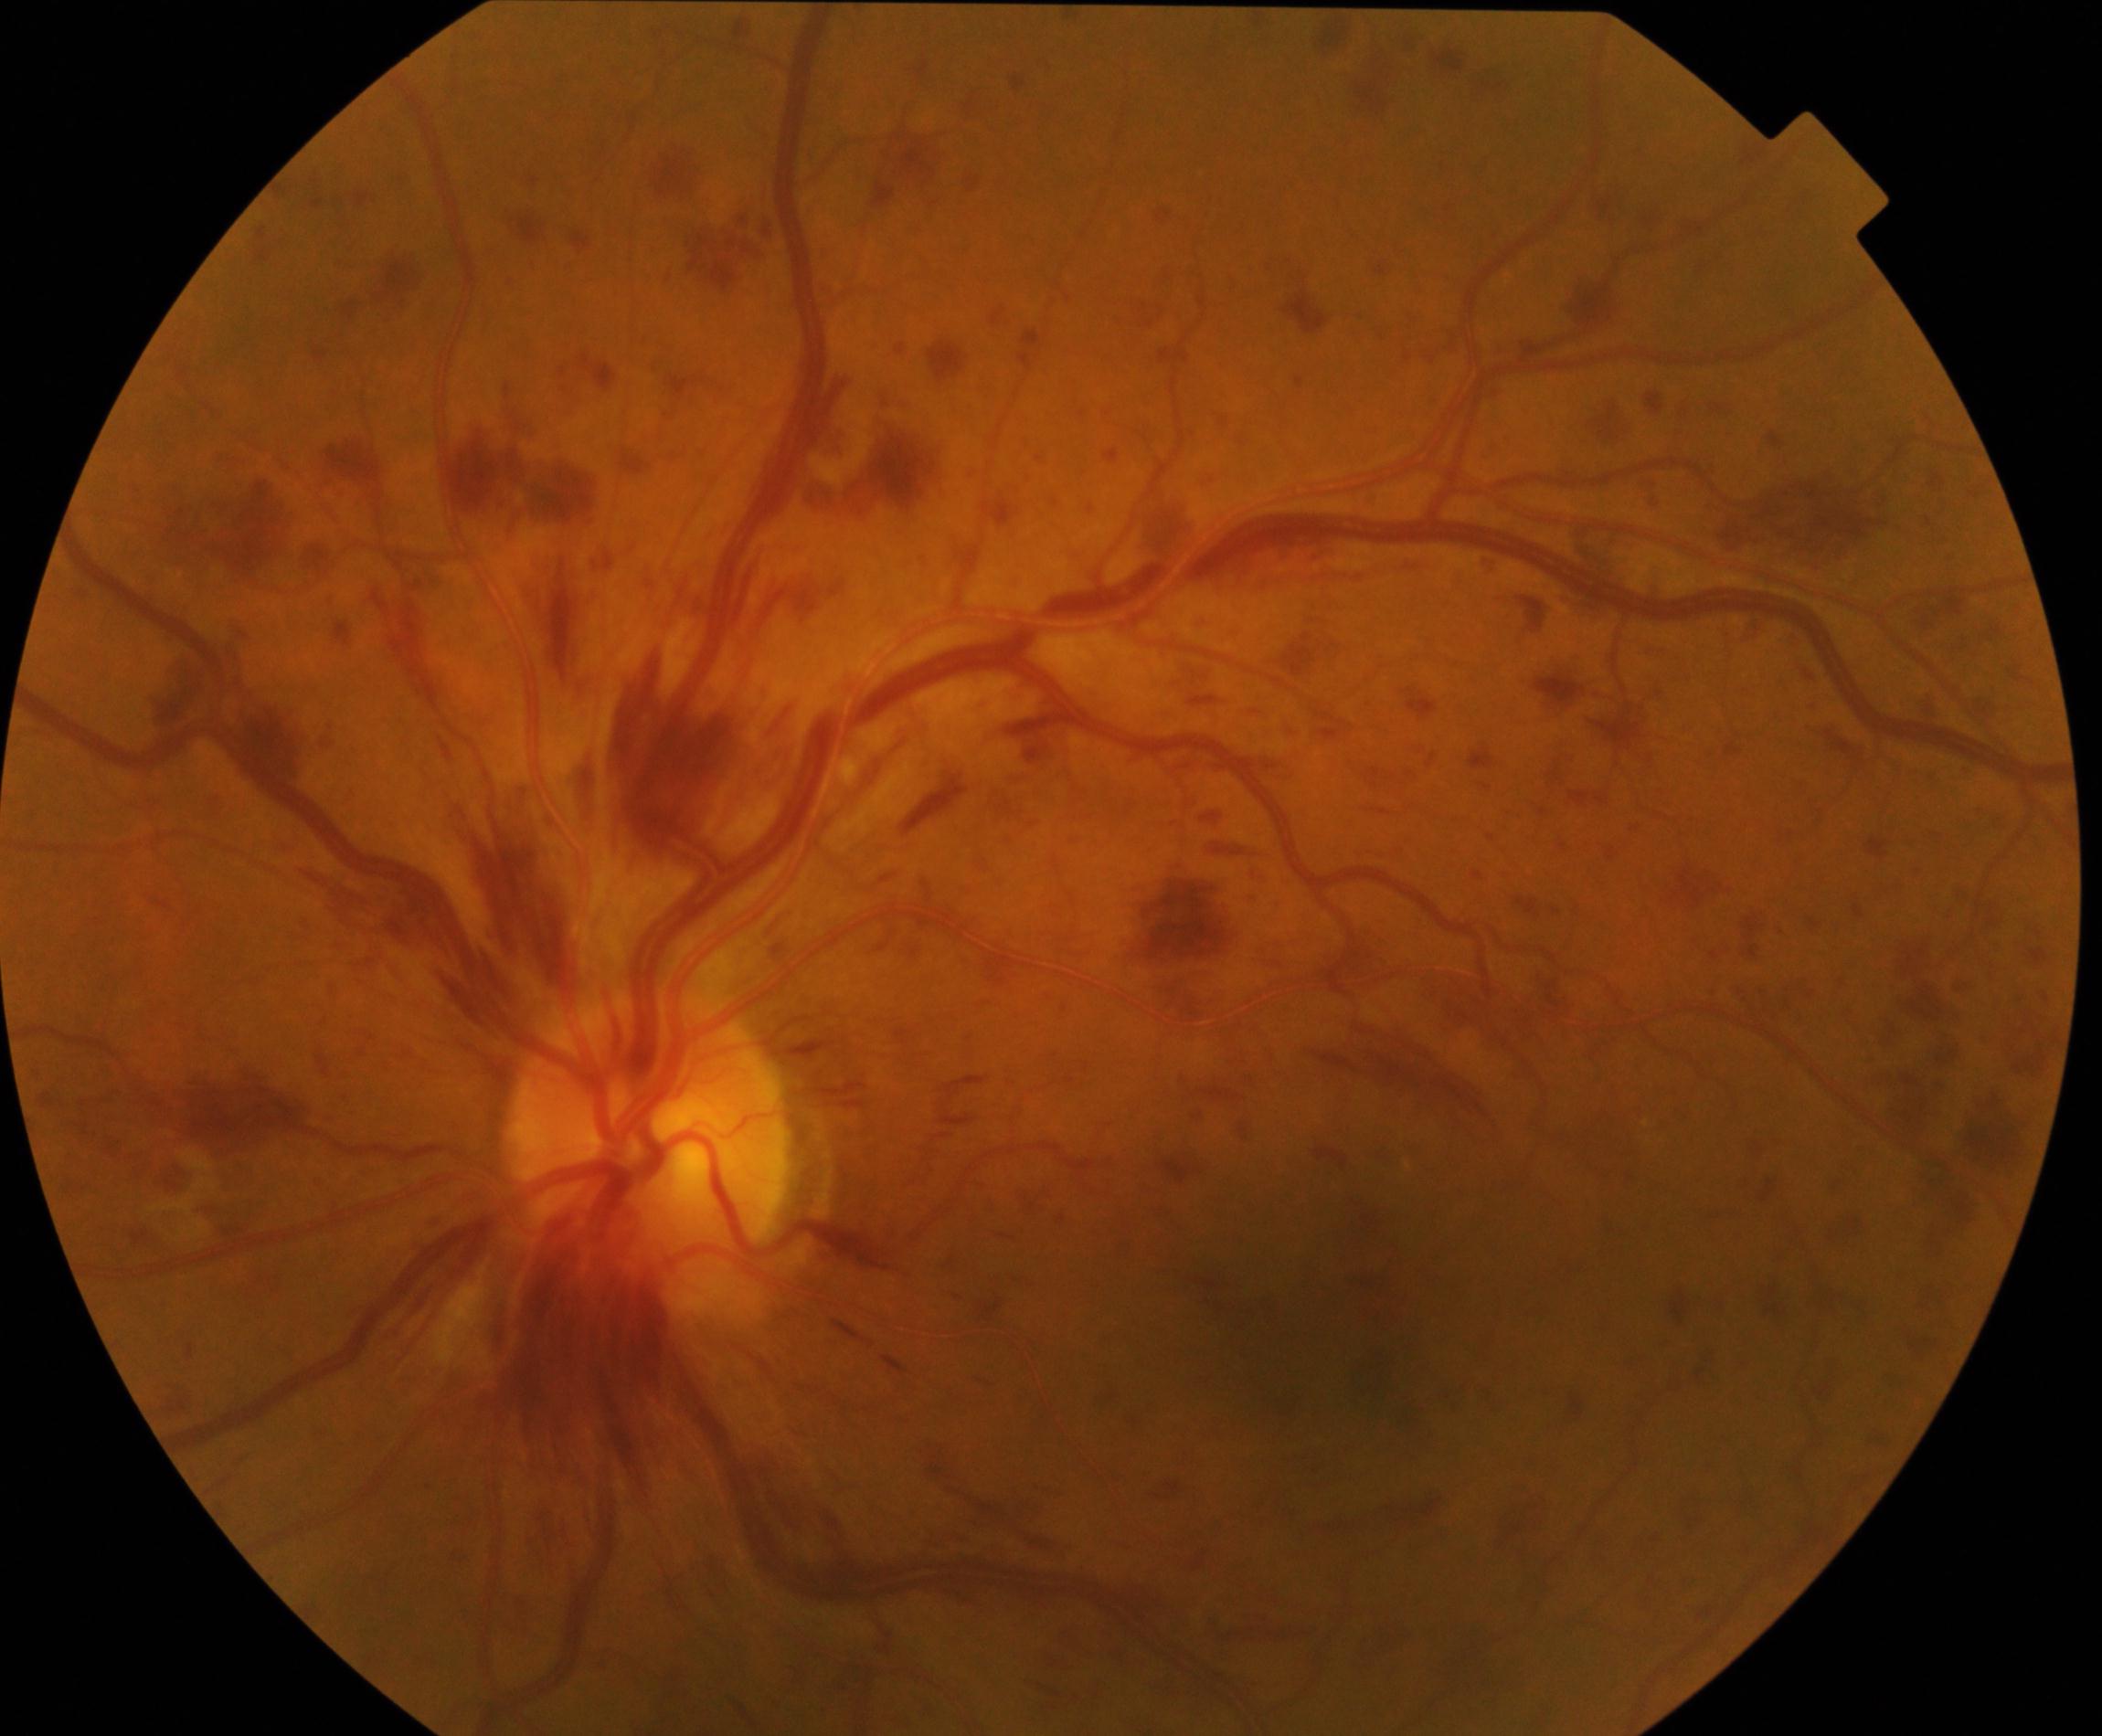
Consistent with central retinal vein occlusion.